Diabetic retinopathy graded by the modified Davis classification — 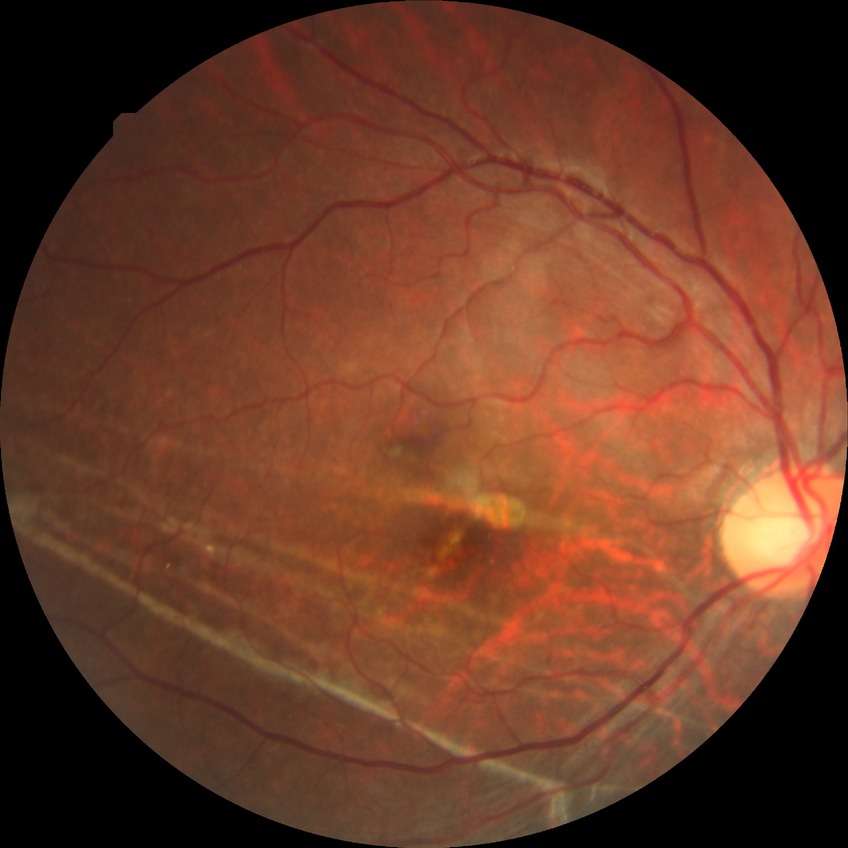 Diabetic retinopathy grade: no diabetic retinopathy.